Infant wide-field retinal image
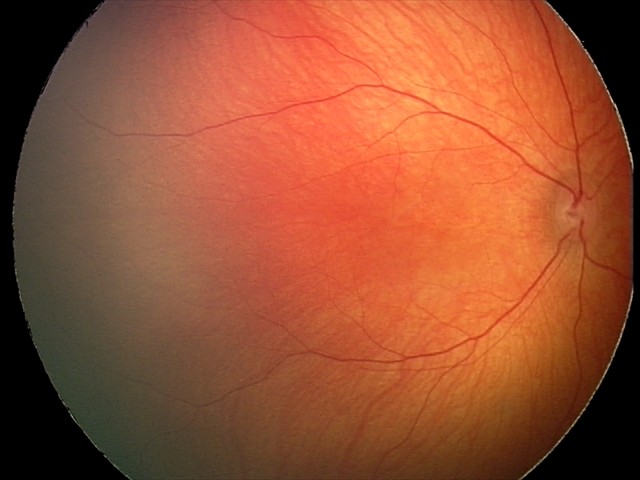 Q: What is the diagnosis from this examination?
A: normal fundus examination